Pediatric wide-field fundus photograph — 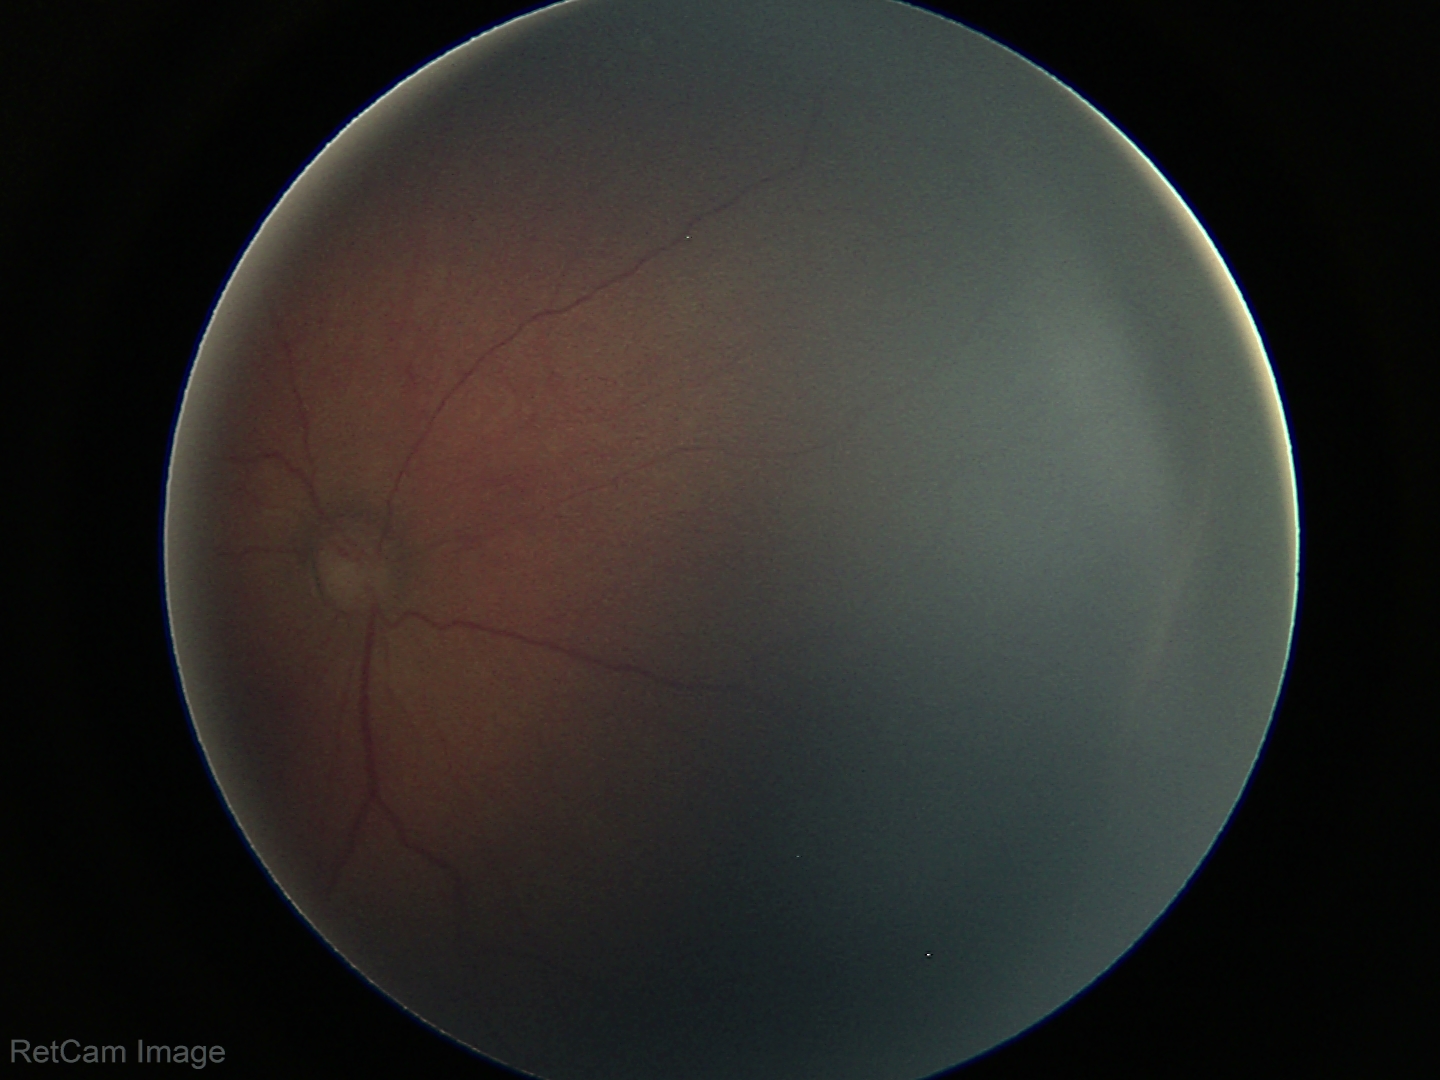

Impression = ROP stage 2 — ridge with height and width at the demarcation line.